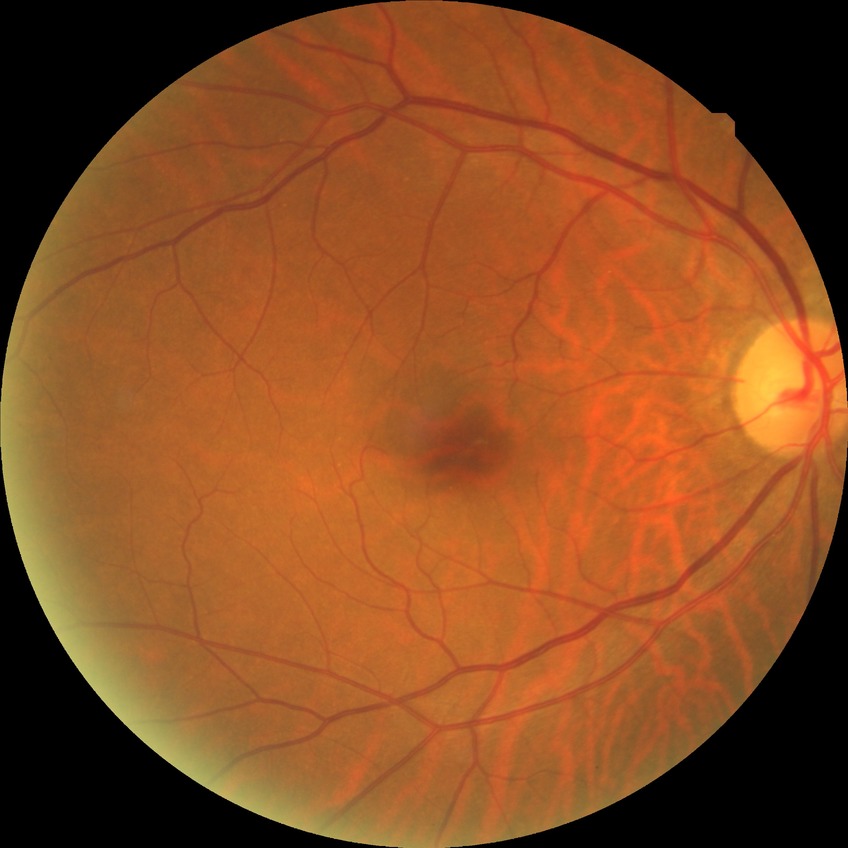

diabetic retinopathy (DR)@no diabetic retinopathy (NDR).